45° FOV · color fundus photograph · 2048x1536px.
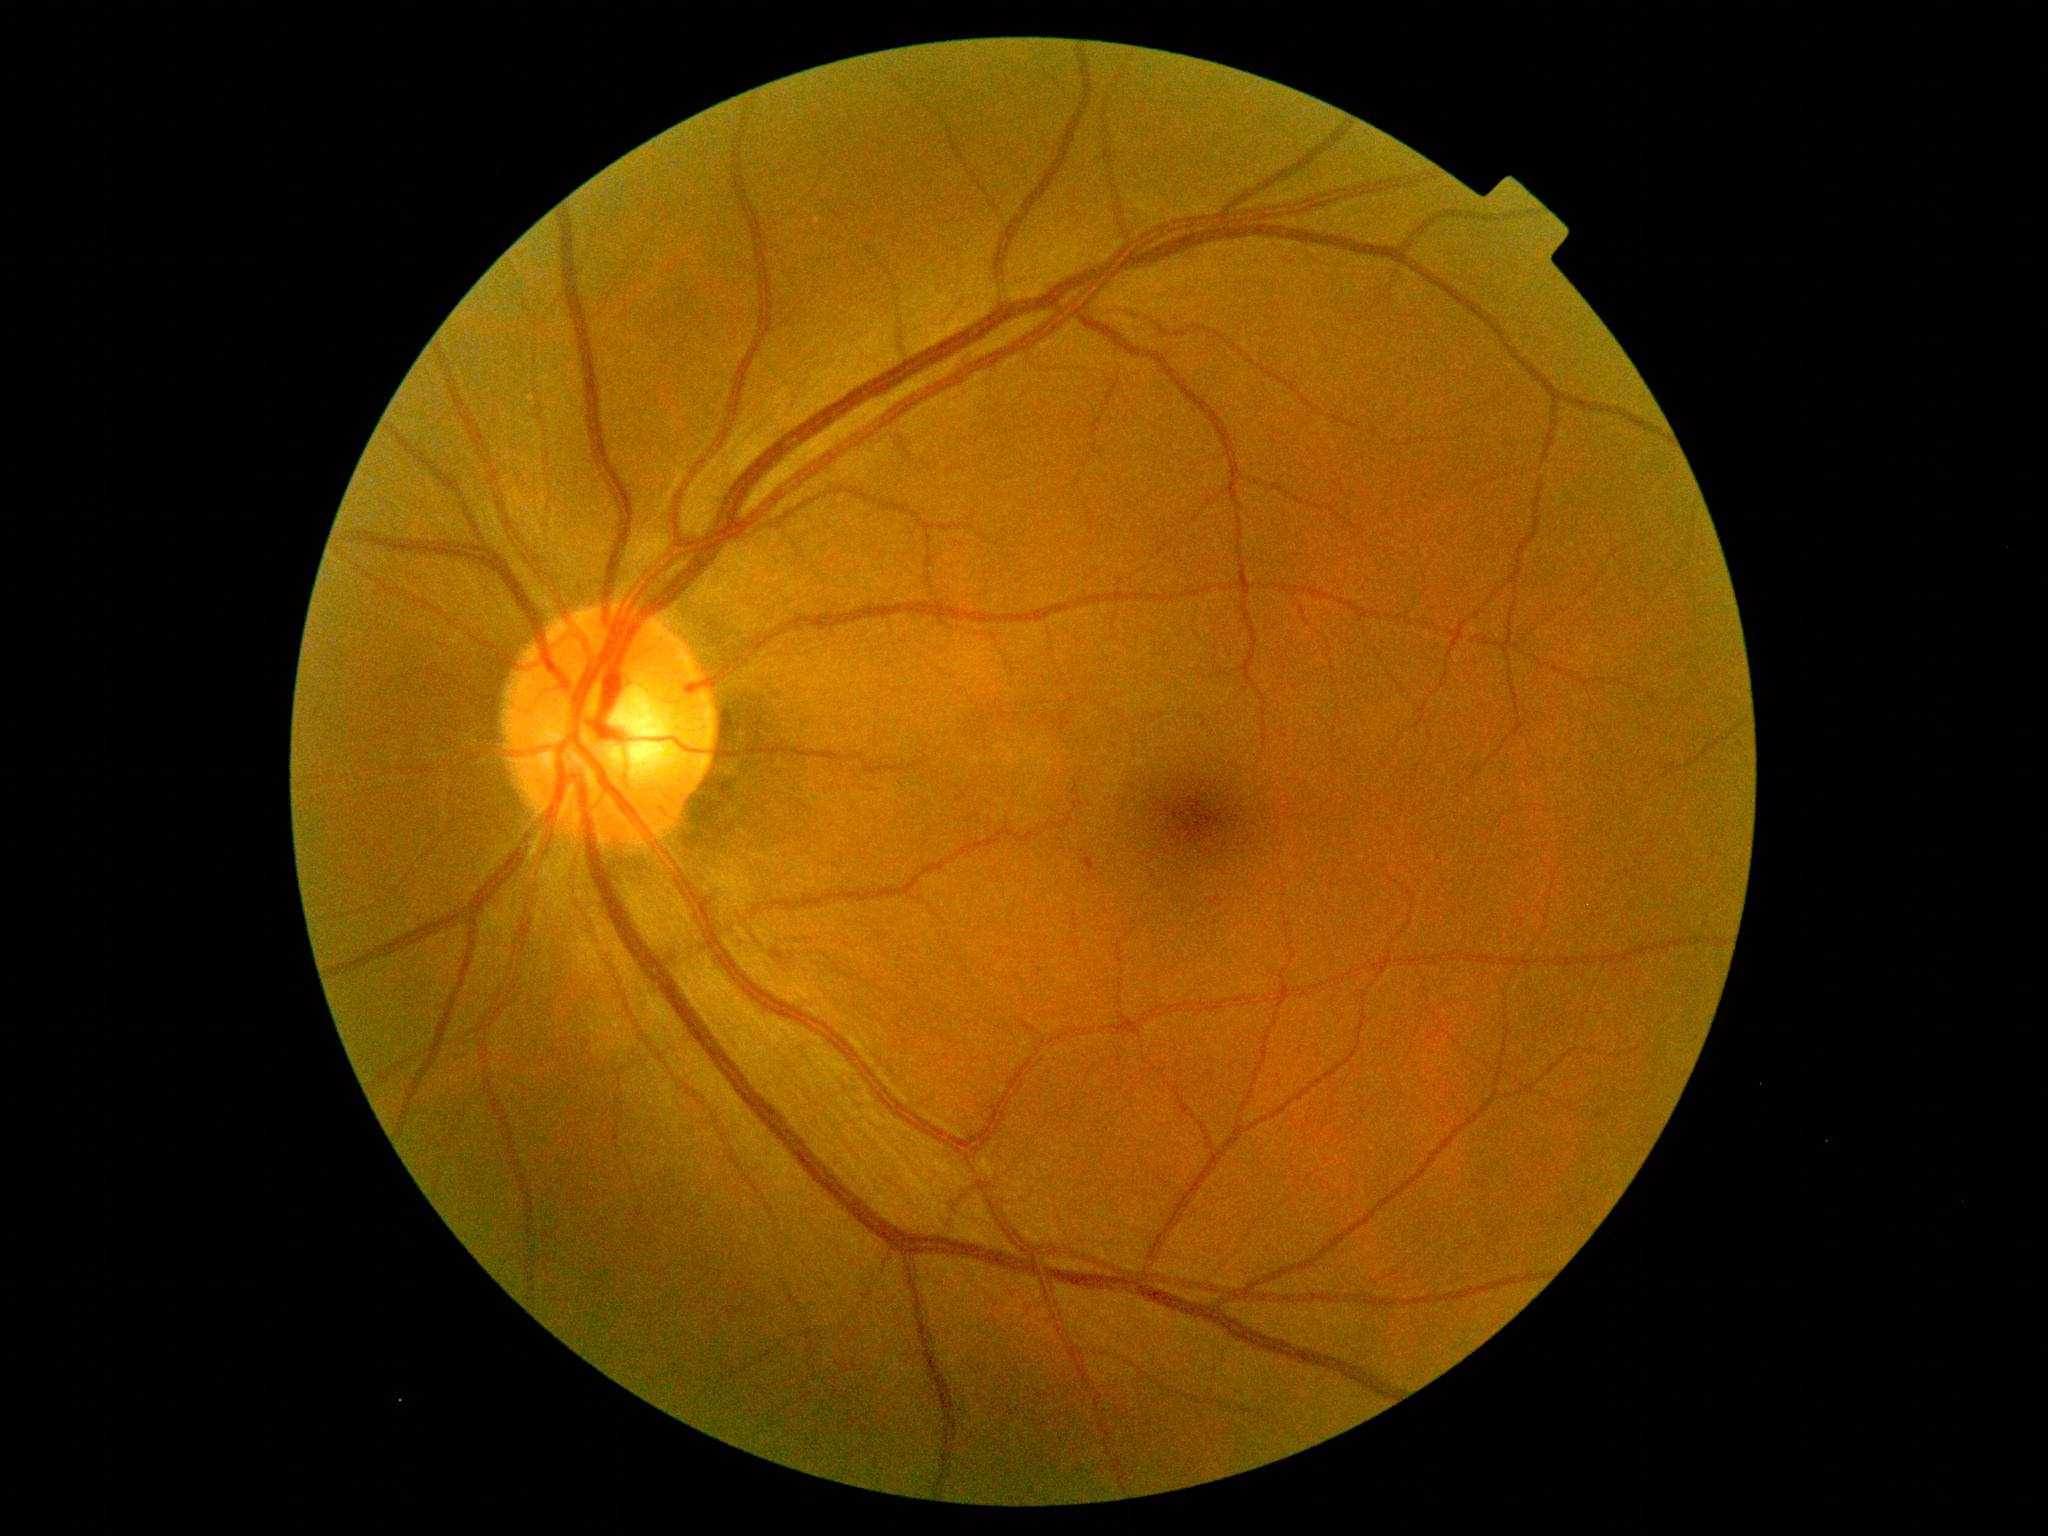

DR class: non-proliferative diabetic retinopathy; DR severity: grade 1 (mild NPDR).